2048 x 1536 pixels; CFP; 45° FOV — 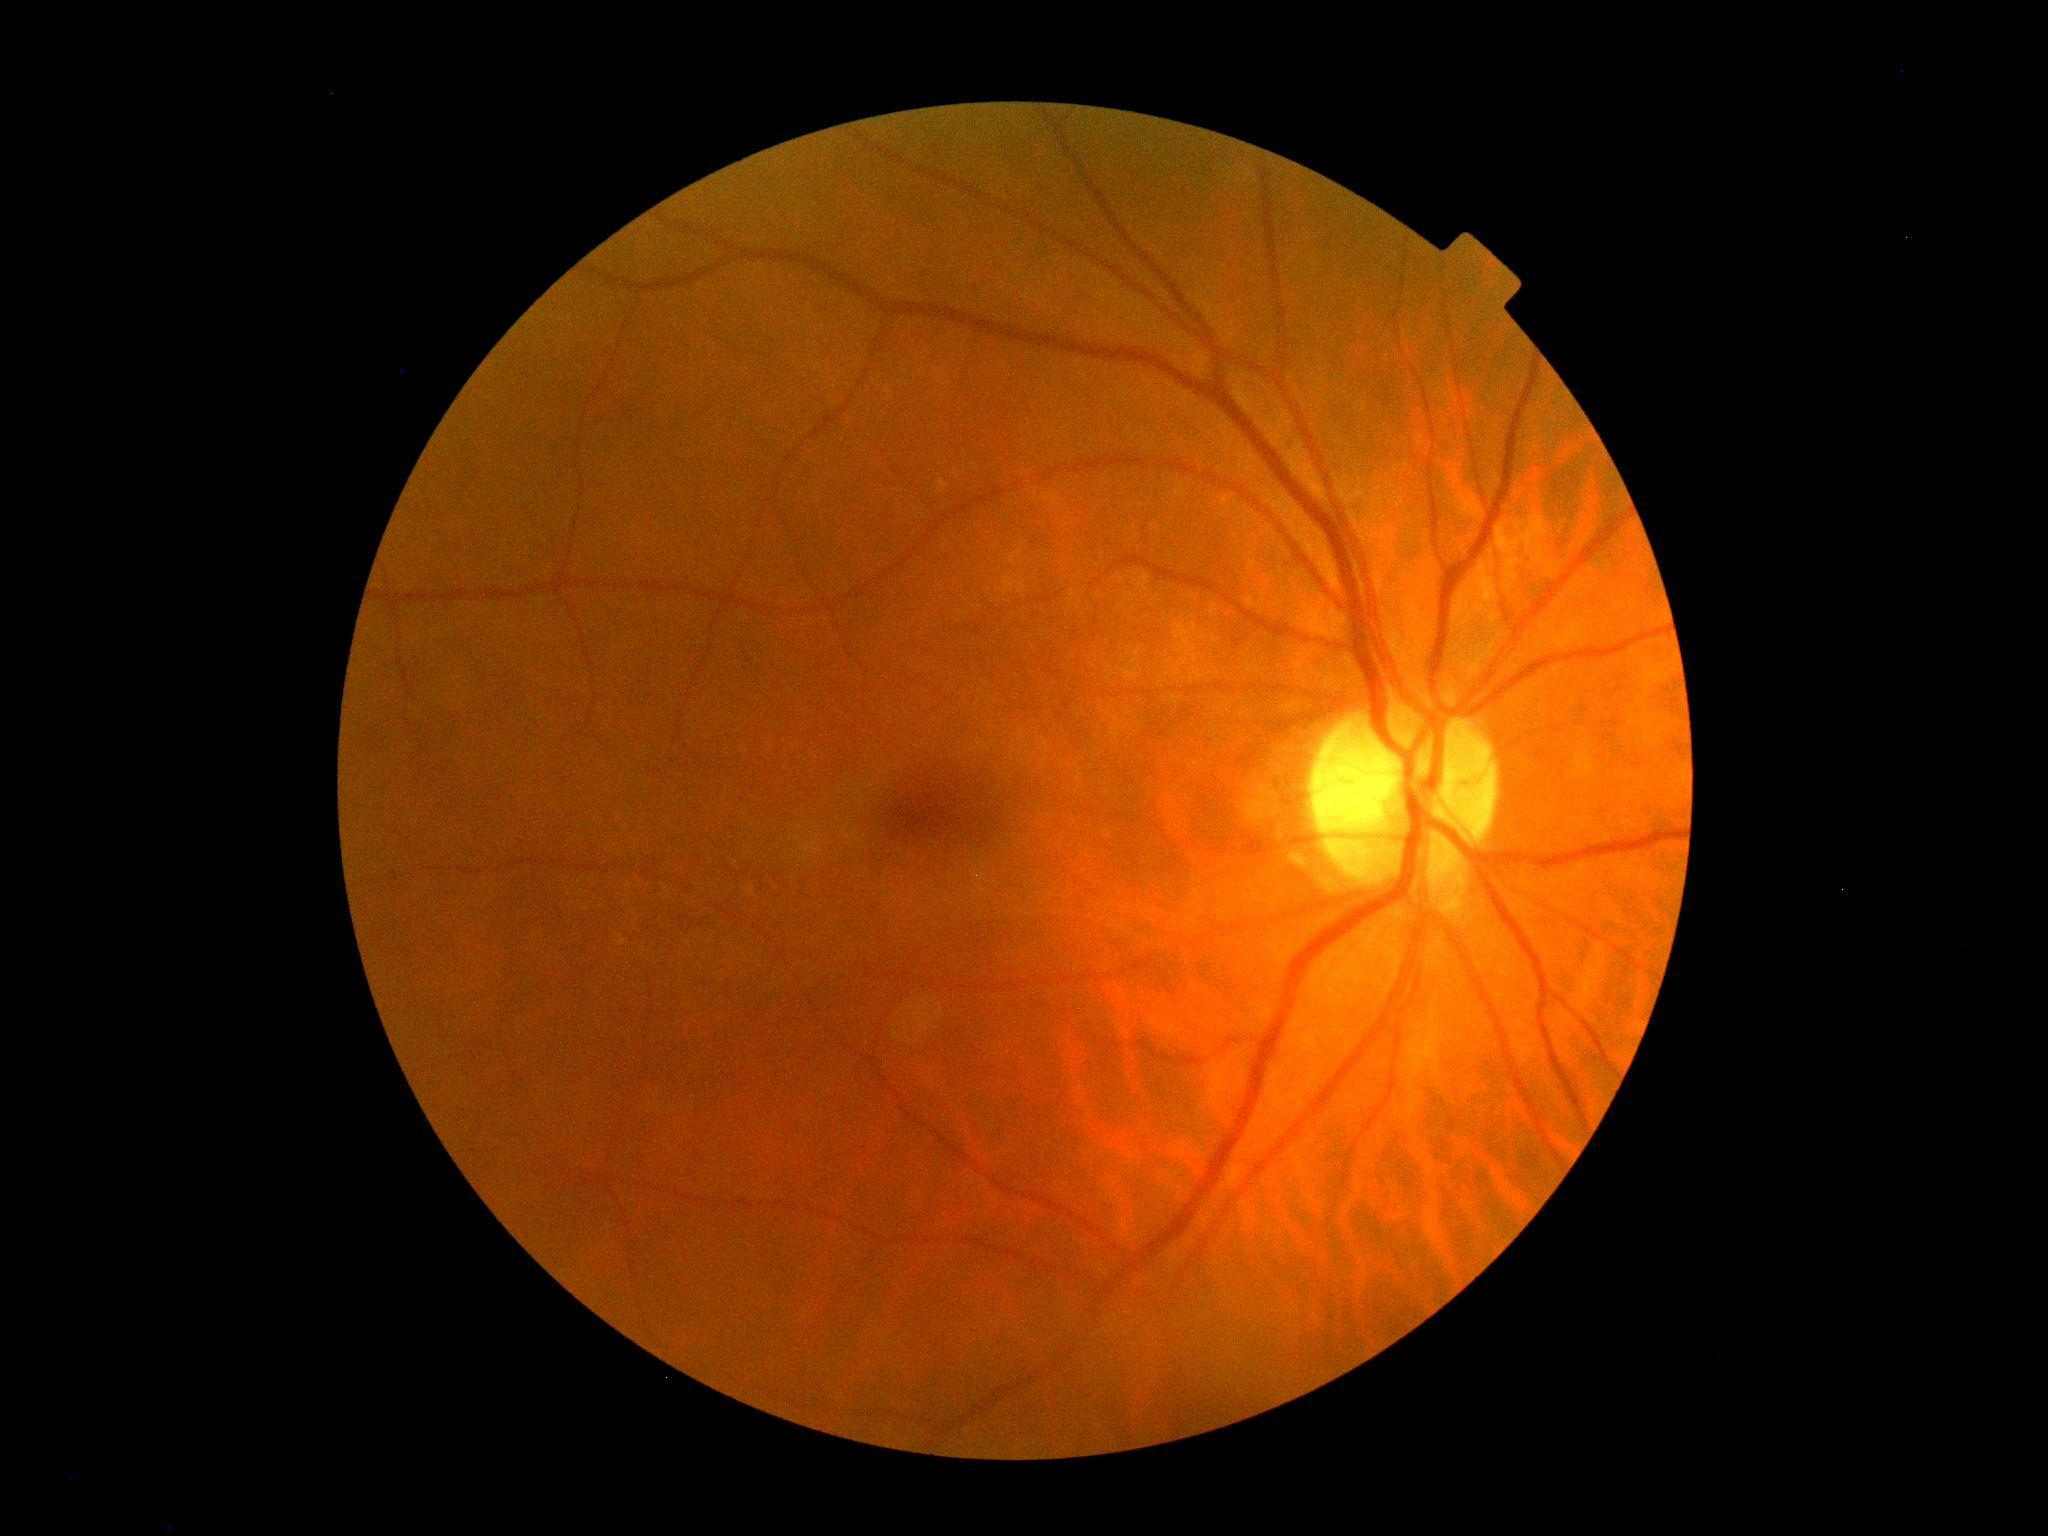 DR severity: grade 0 (no apparent retinopathy).
No DR findings.